Pediatric wide-field fundus photograph
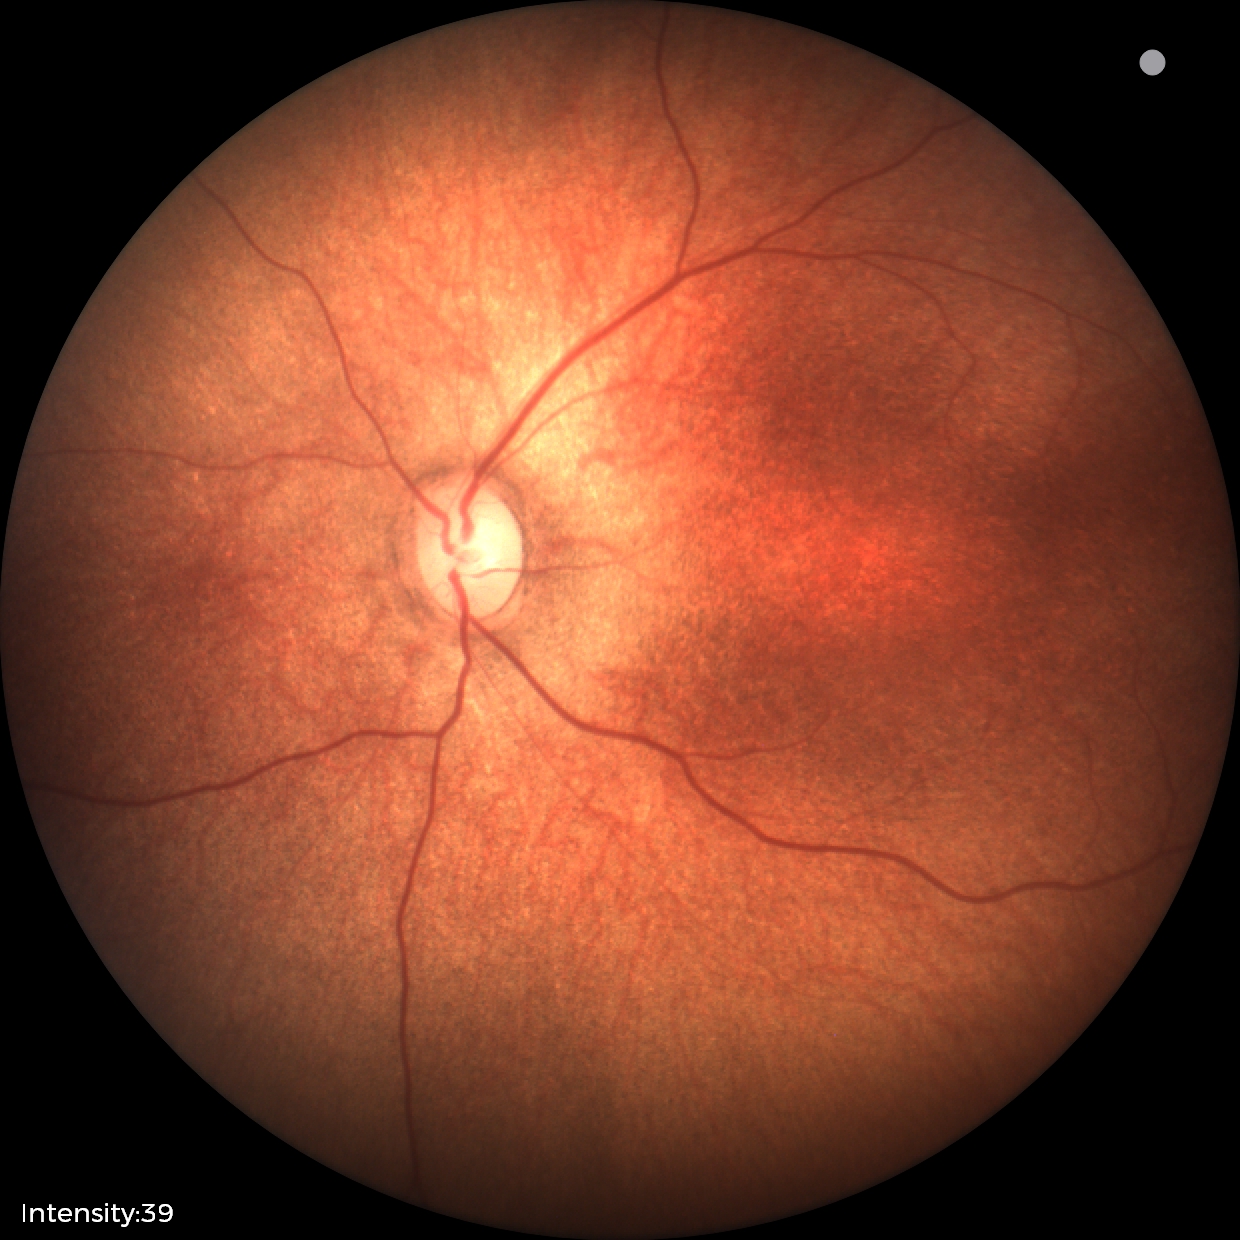
Examination with physiological retinal findings.